Fundus photo taken with a portable handheld camera; 2212 by 1659 pixels.
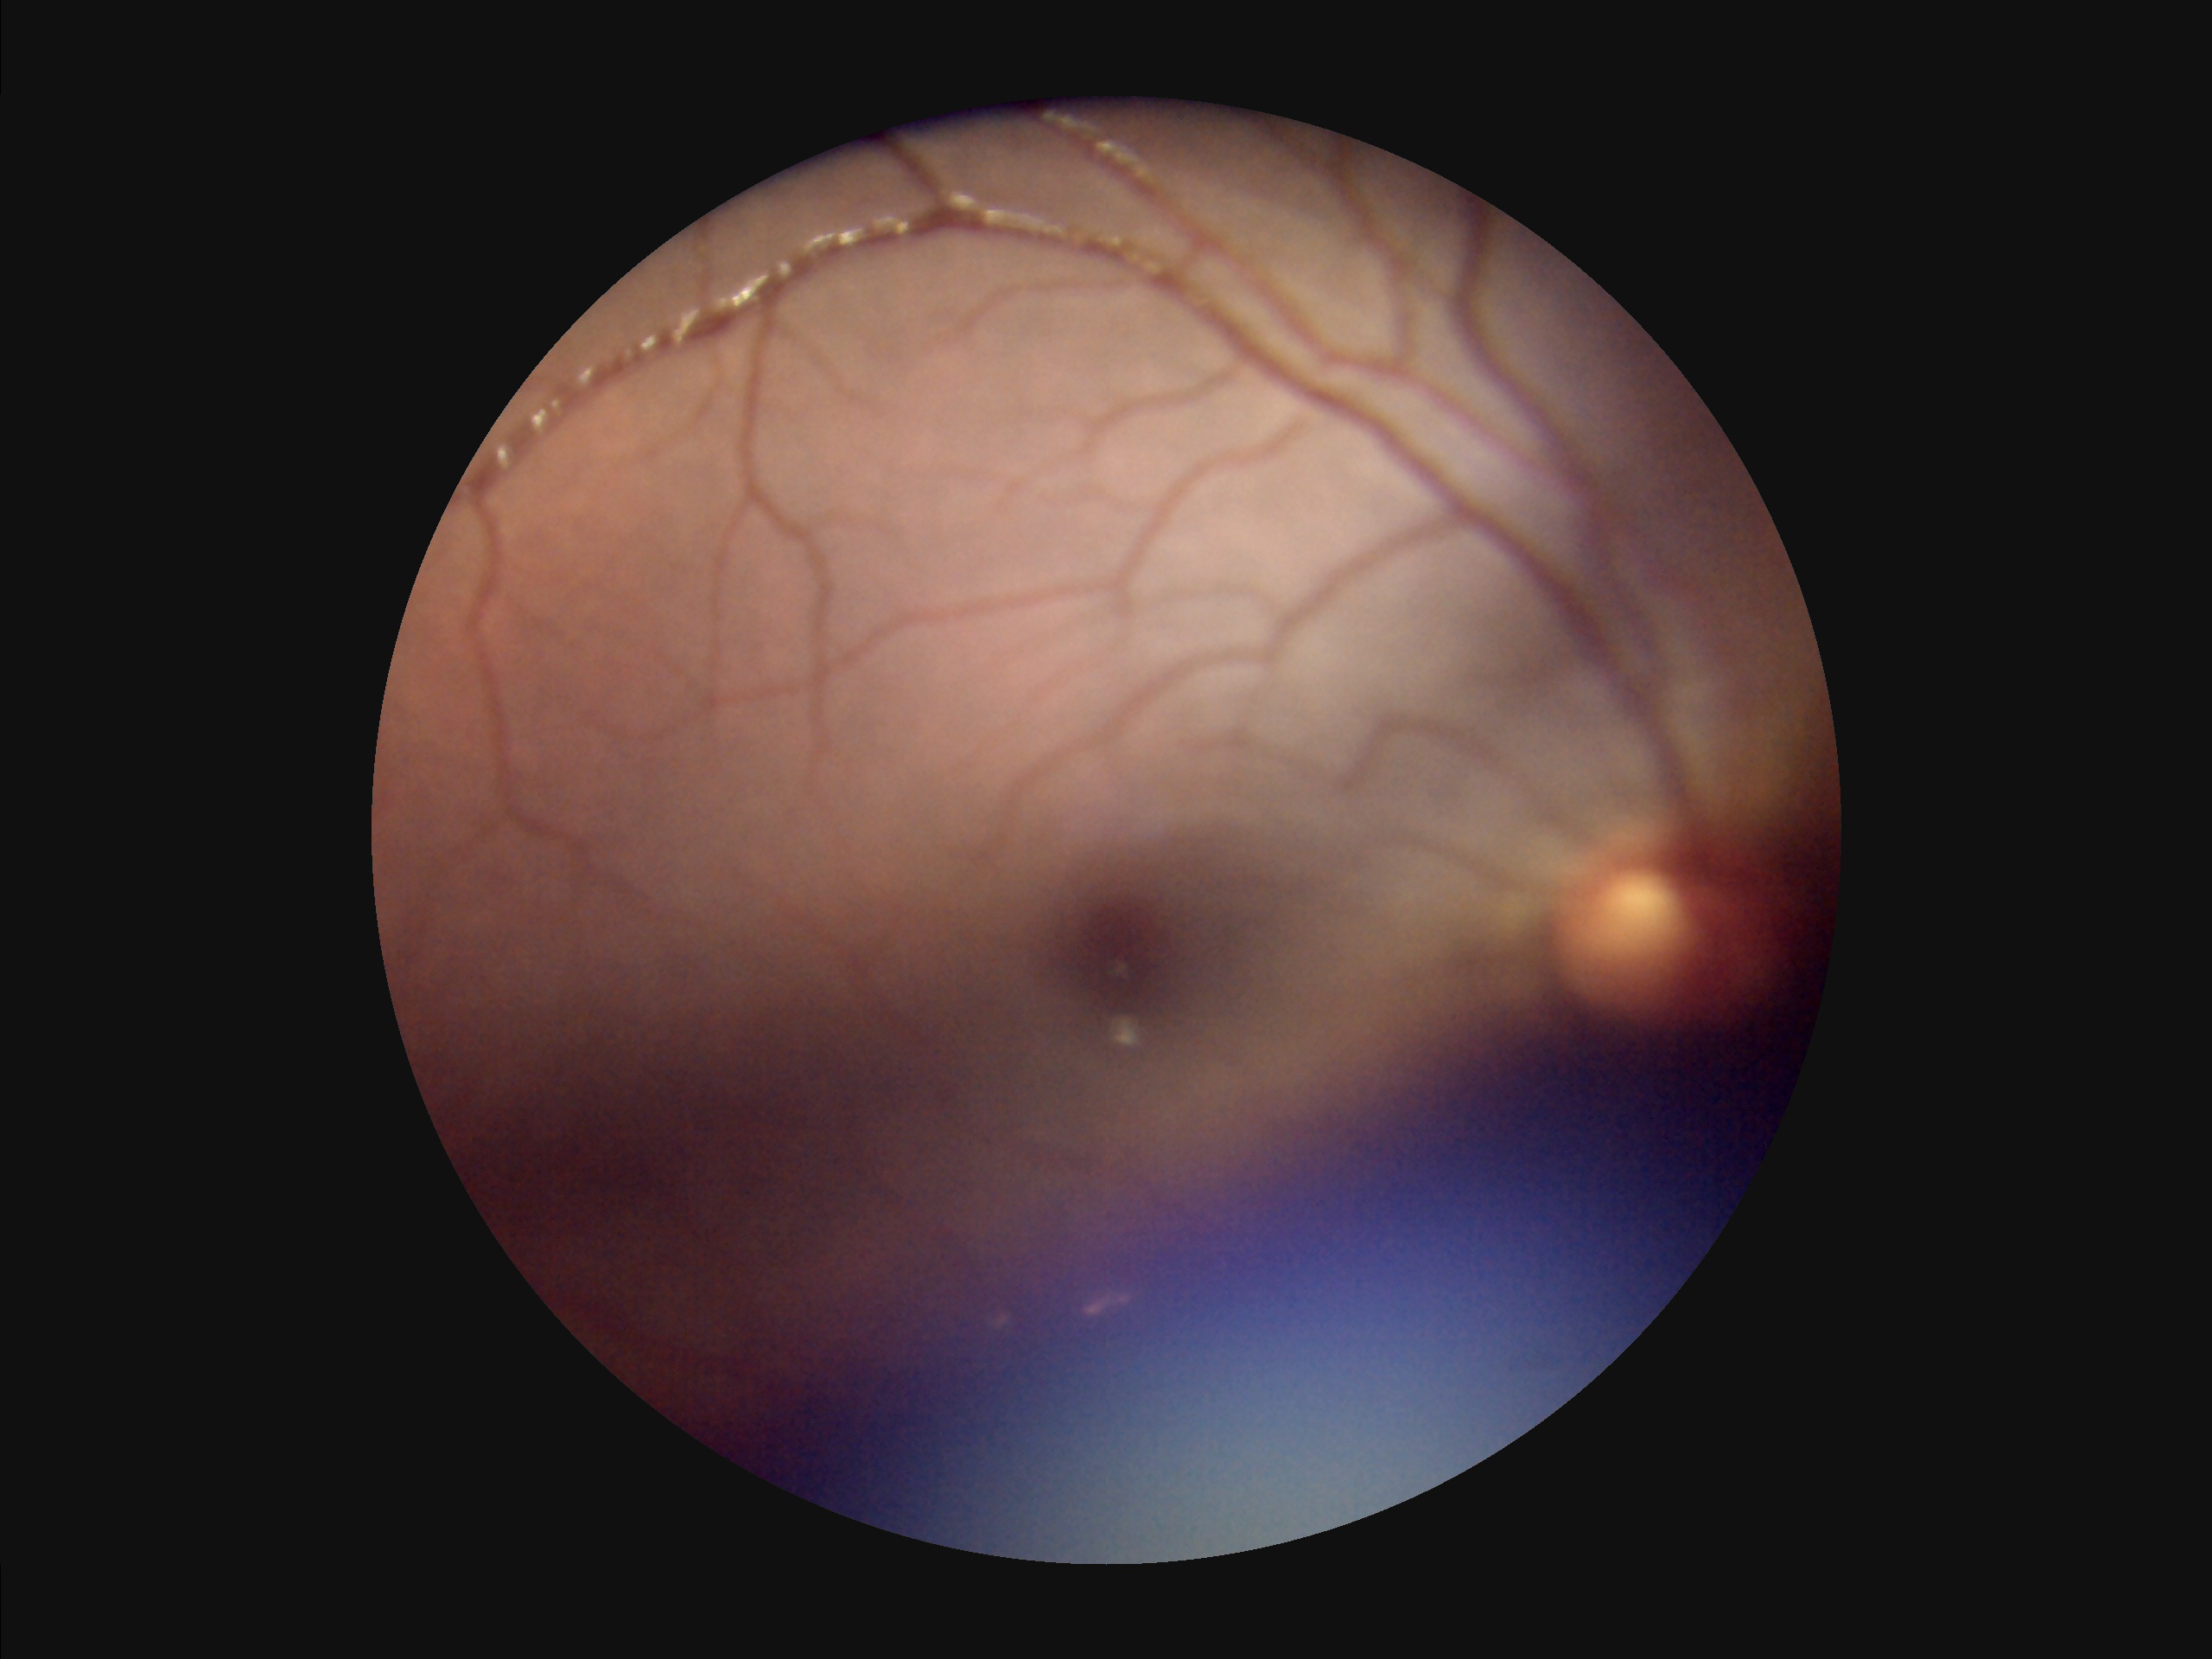

{"clarity": "reduced", "overall_quality": "suboptimal", "illumination": "suboptimal", "contrast": "low"}